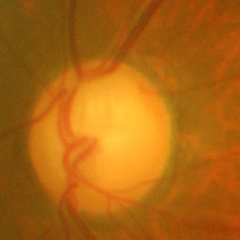
Glaucomatous optic neuropathy is present. Fundus appearance consistent with advanced glaucomatous optic neuropathy.